45° FOV · NIDEK AFC-230 — 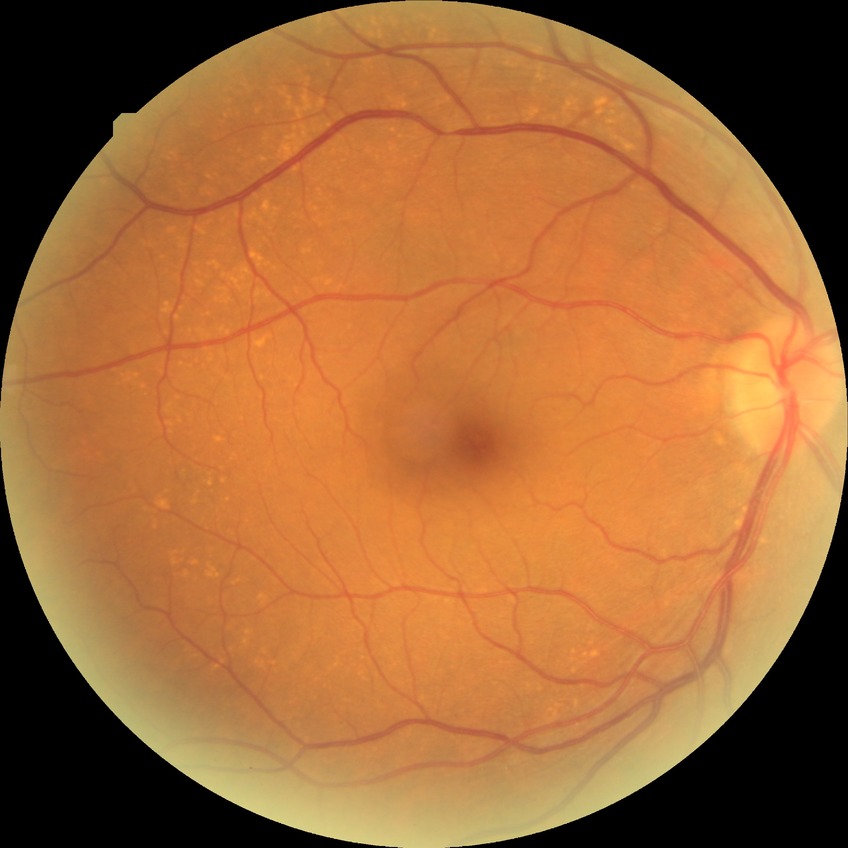 Annotations:
- DR impression: no signs of DR
- modified Davis grade: NDR